2048 x 1536 pixels · retinal fundus photograph.
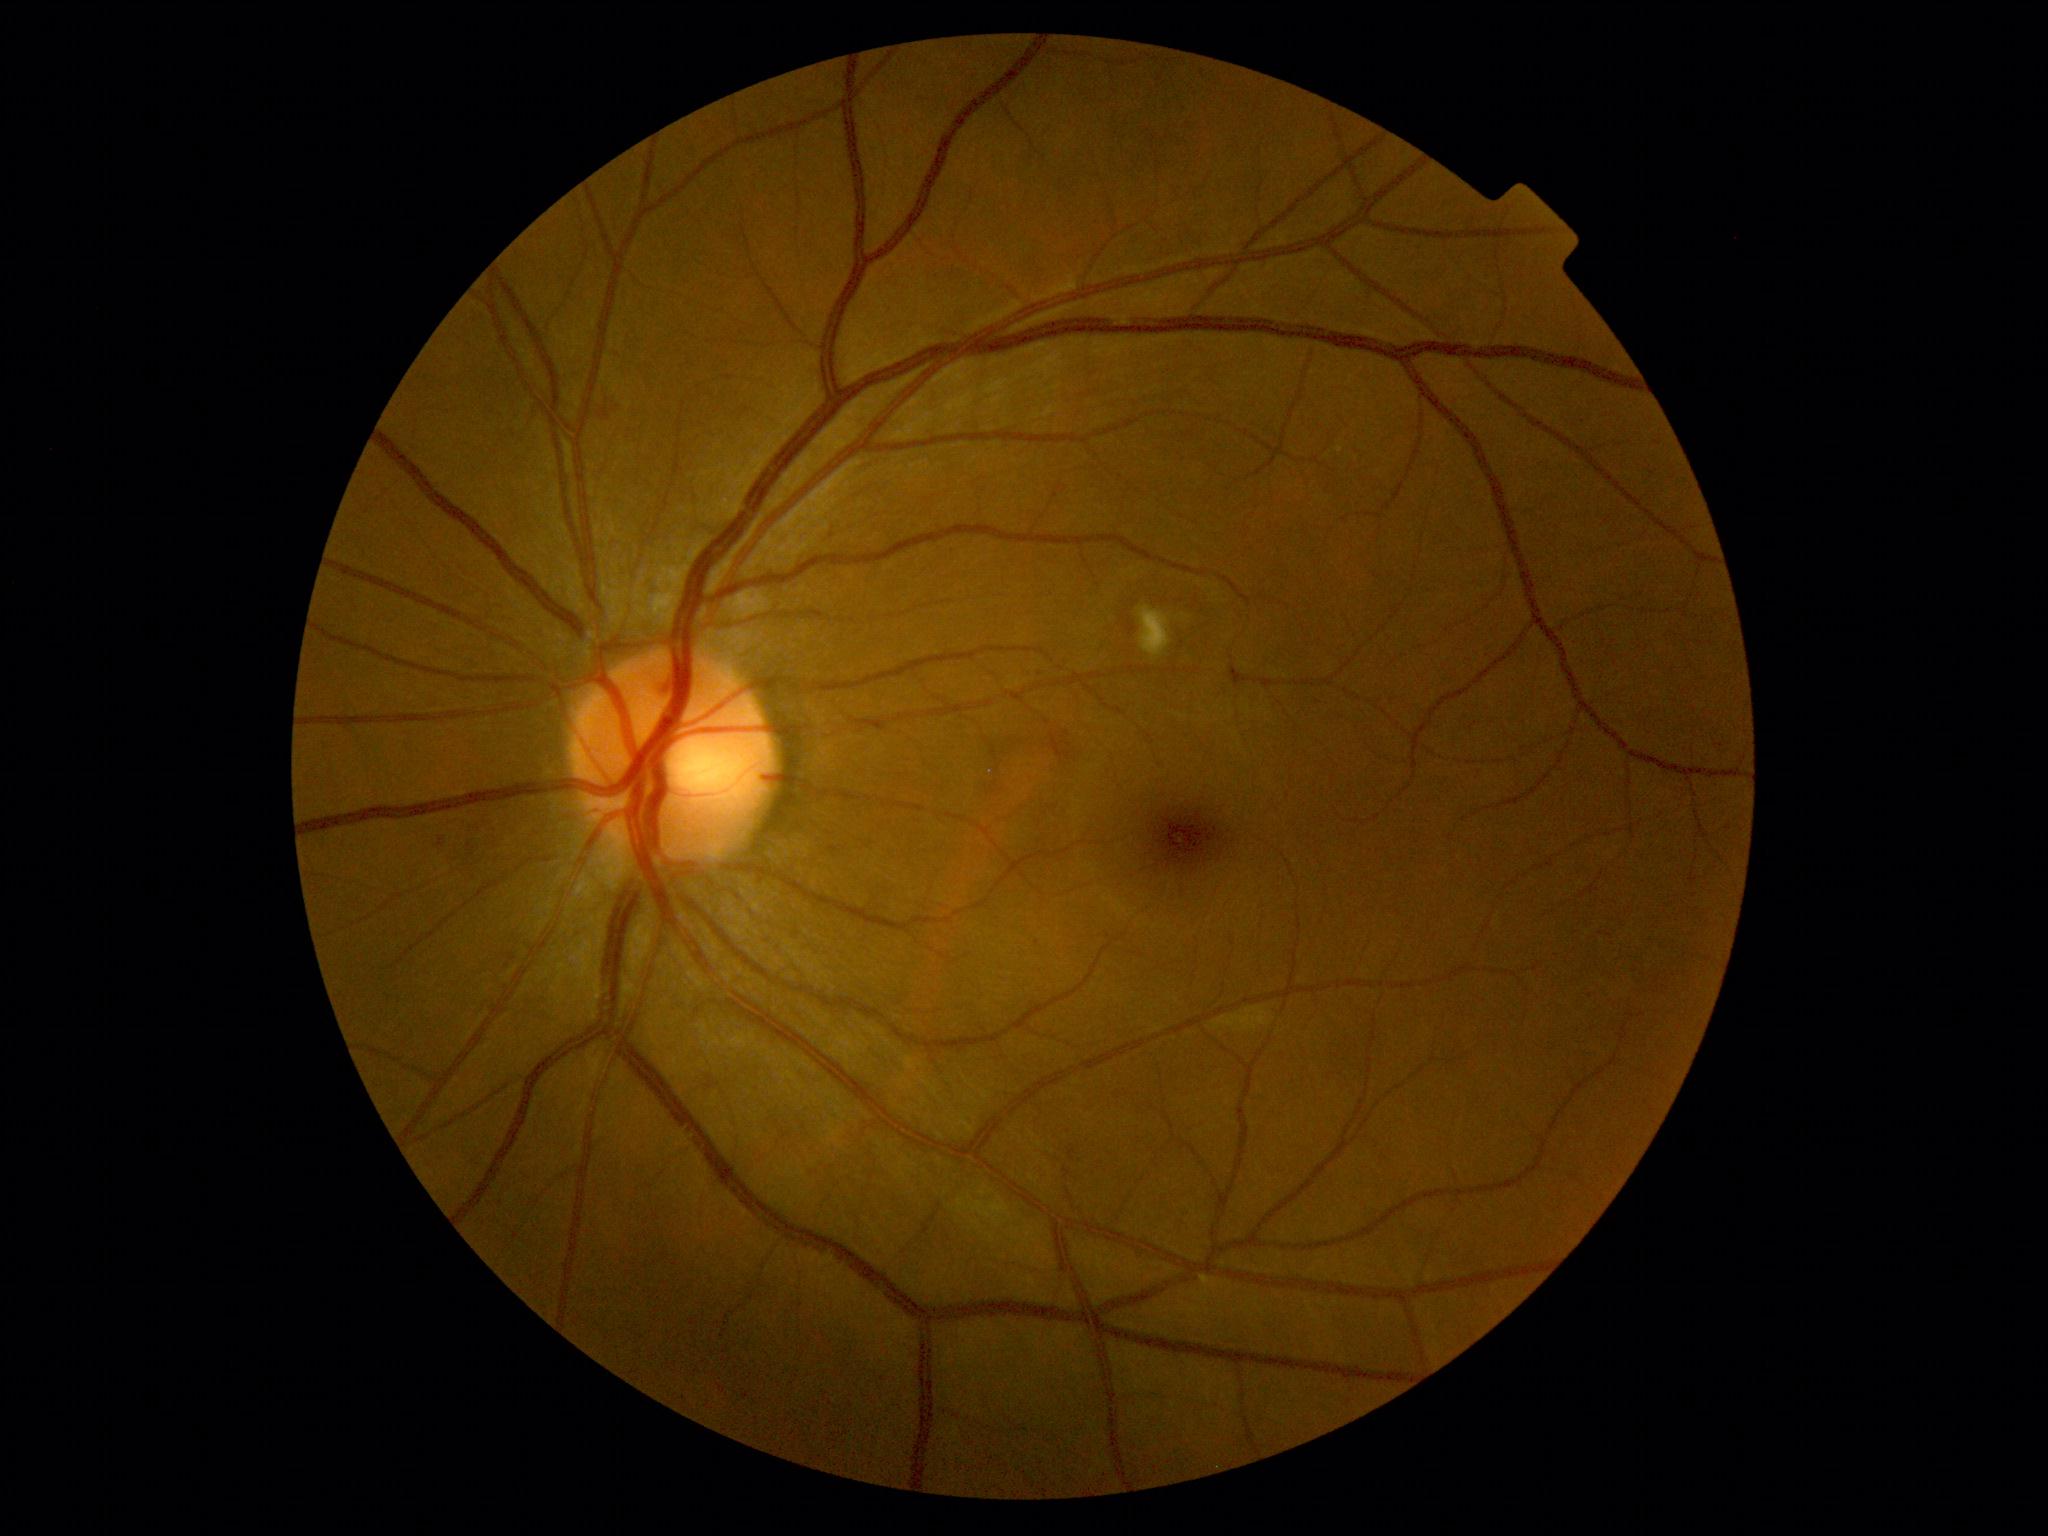
DR stage@2 — more than just microaneurysms but less than severe NPDR.